Acquired with a NIDEK AFC-230; color fundus photograph.
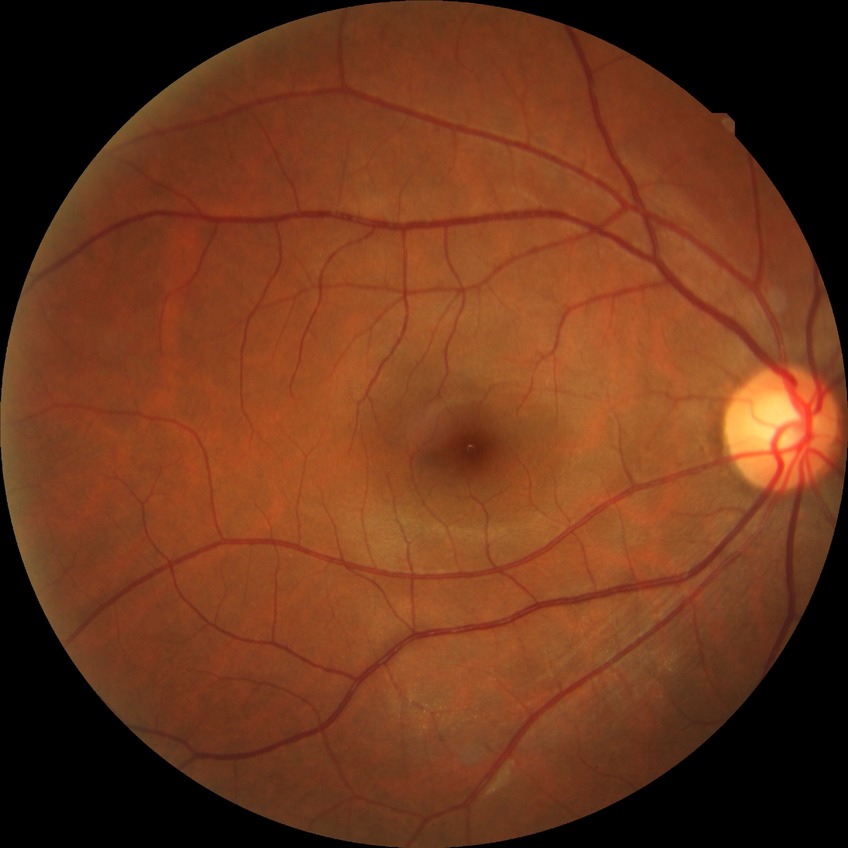

DR impression = no apparent DR; Davis grade = NDR.